Captured on a Remidio FOP fundus camera · 1659 x 2212 pixels.
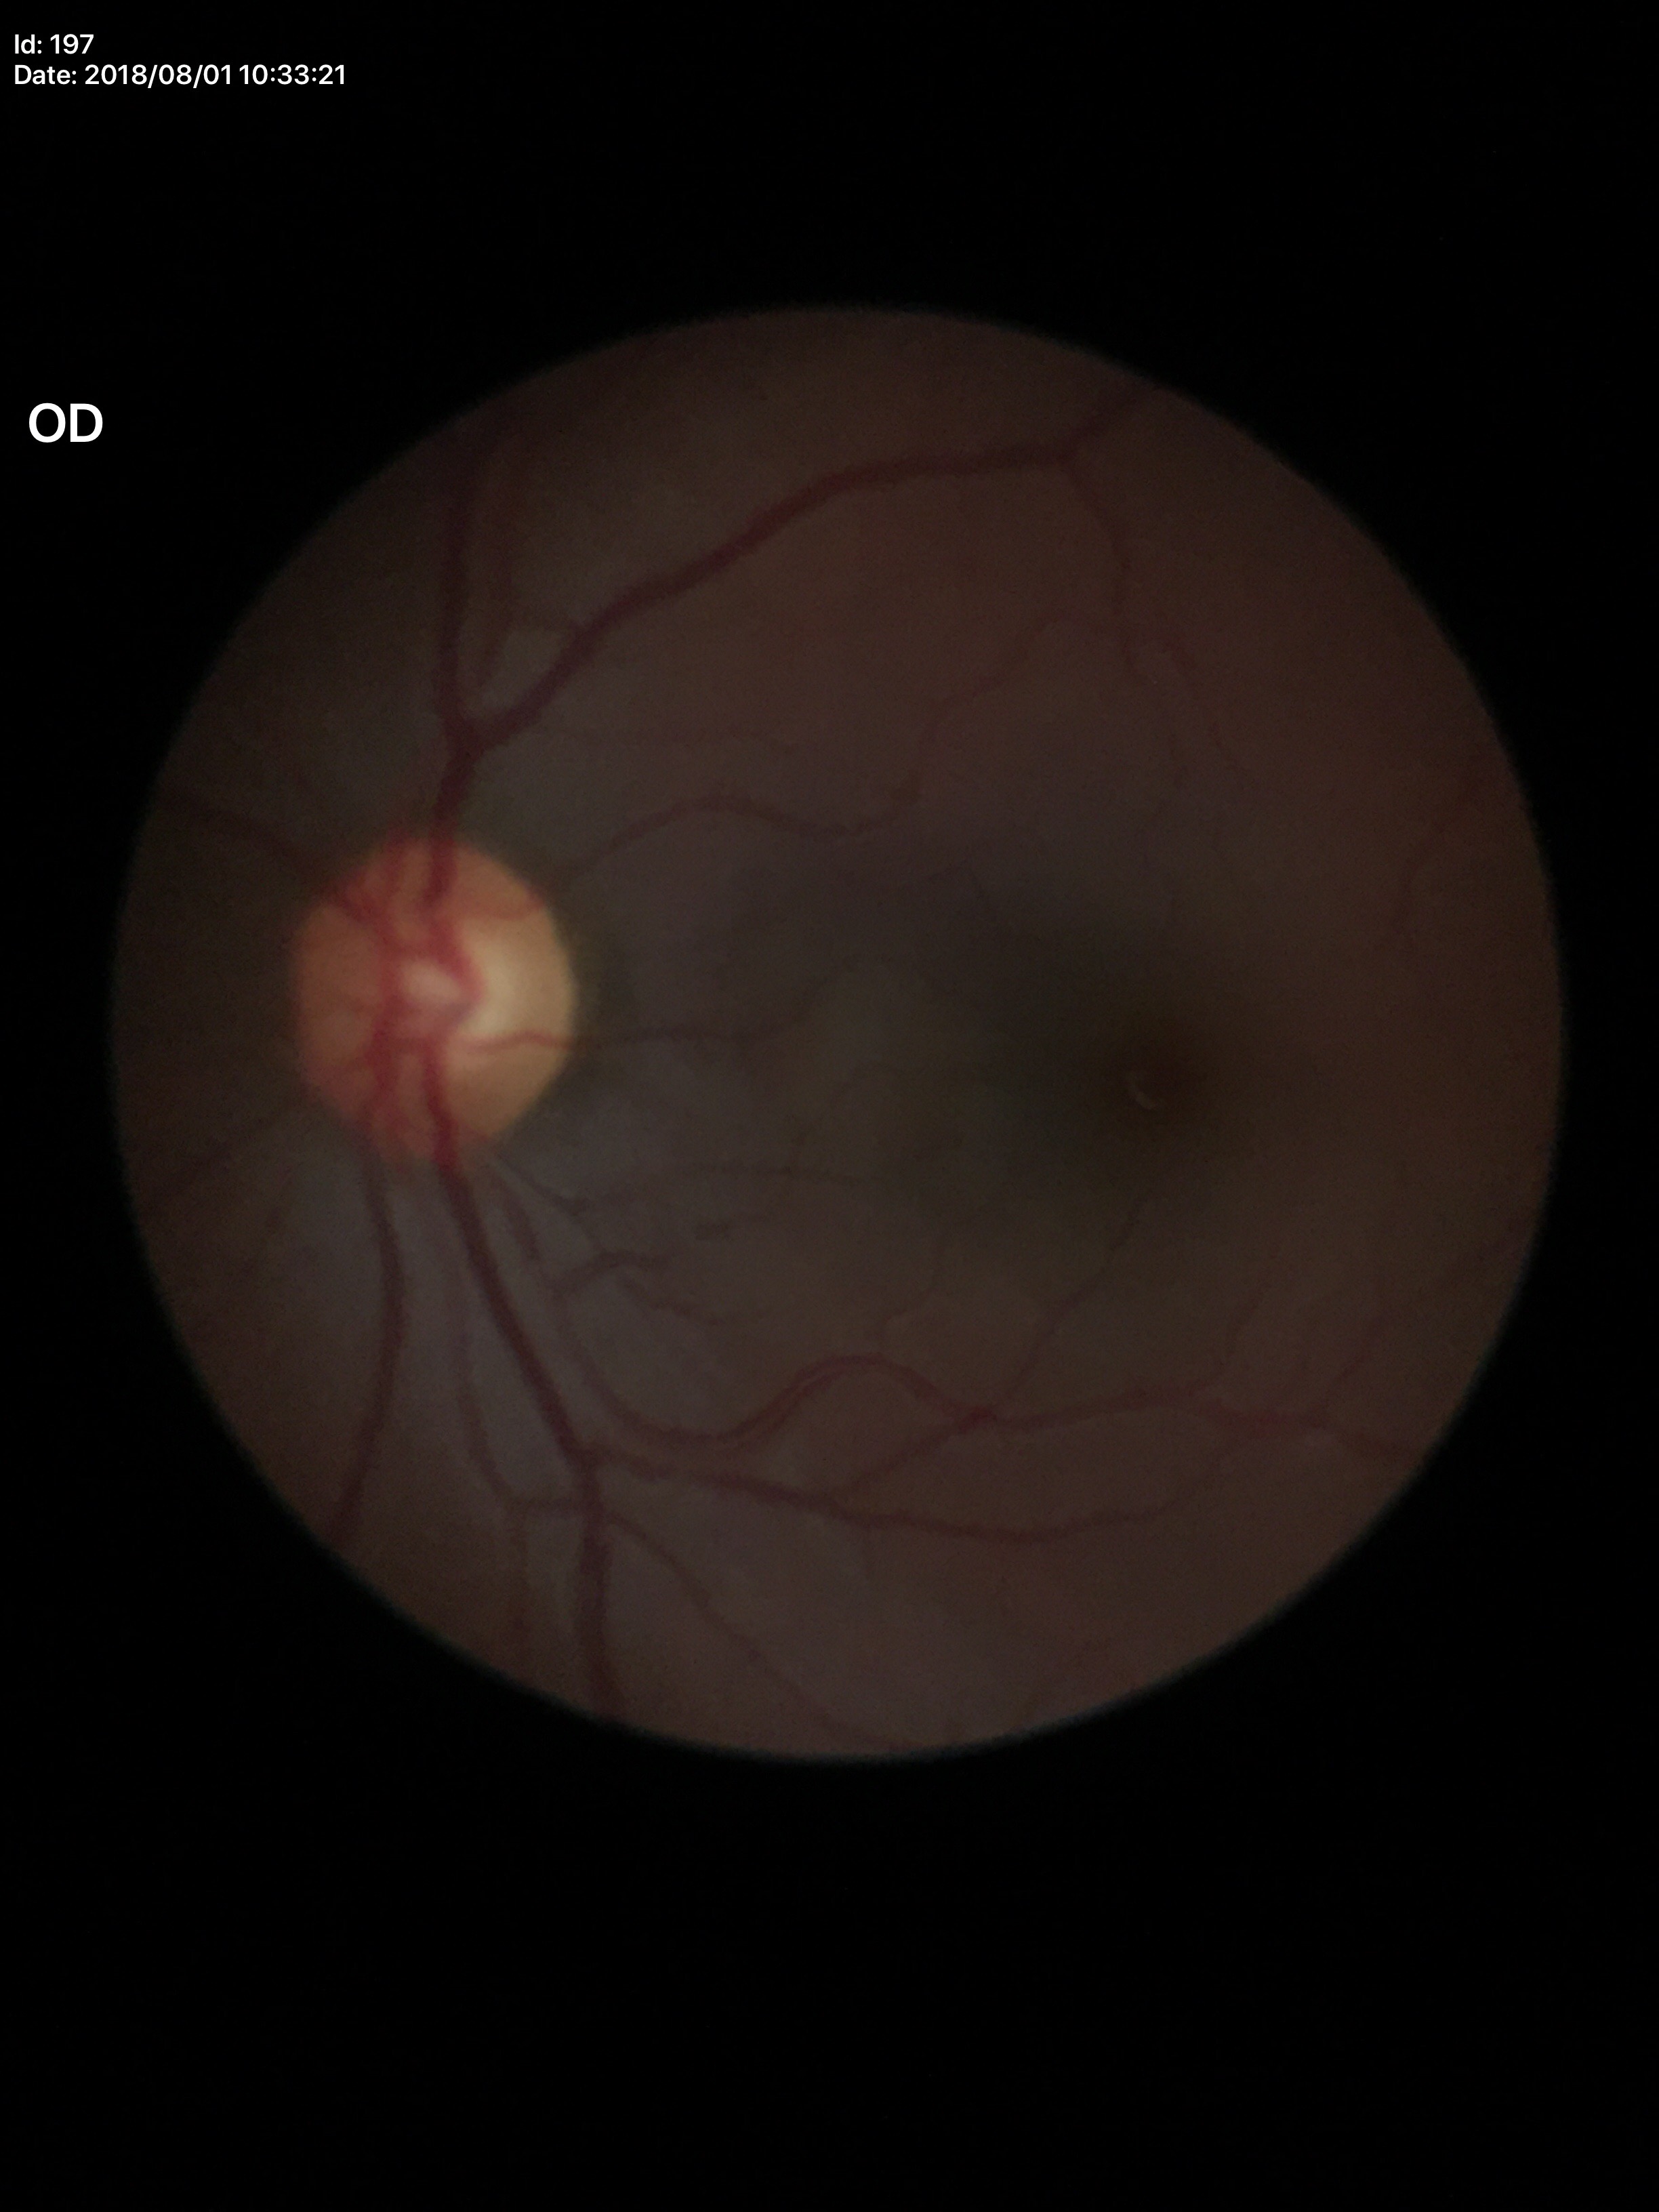

Glaucoma screening: no suspicious findings; vertical CDR (VCDR): 0.52; horizontal cup-disc ratio (HCDR): 0.55; area CDR (ACDR): 0.30.